45-degree field of view · 2352x1568px
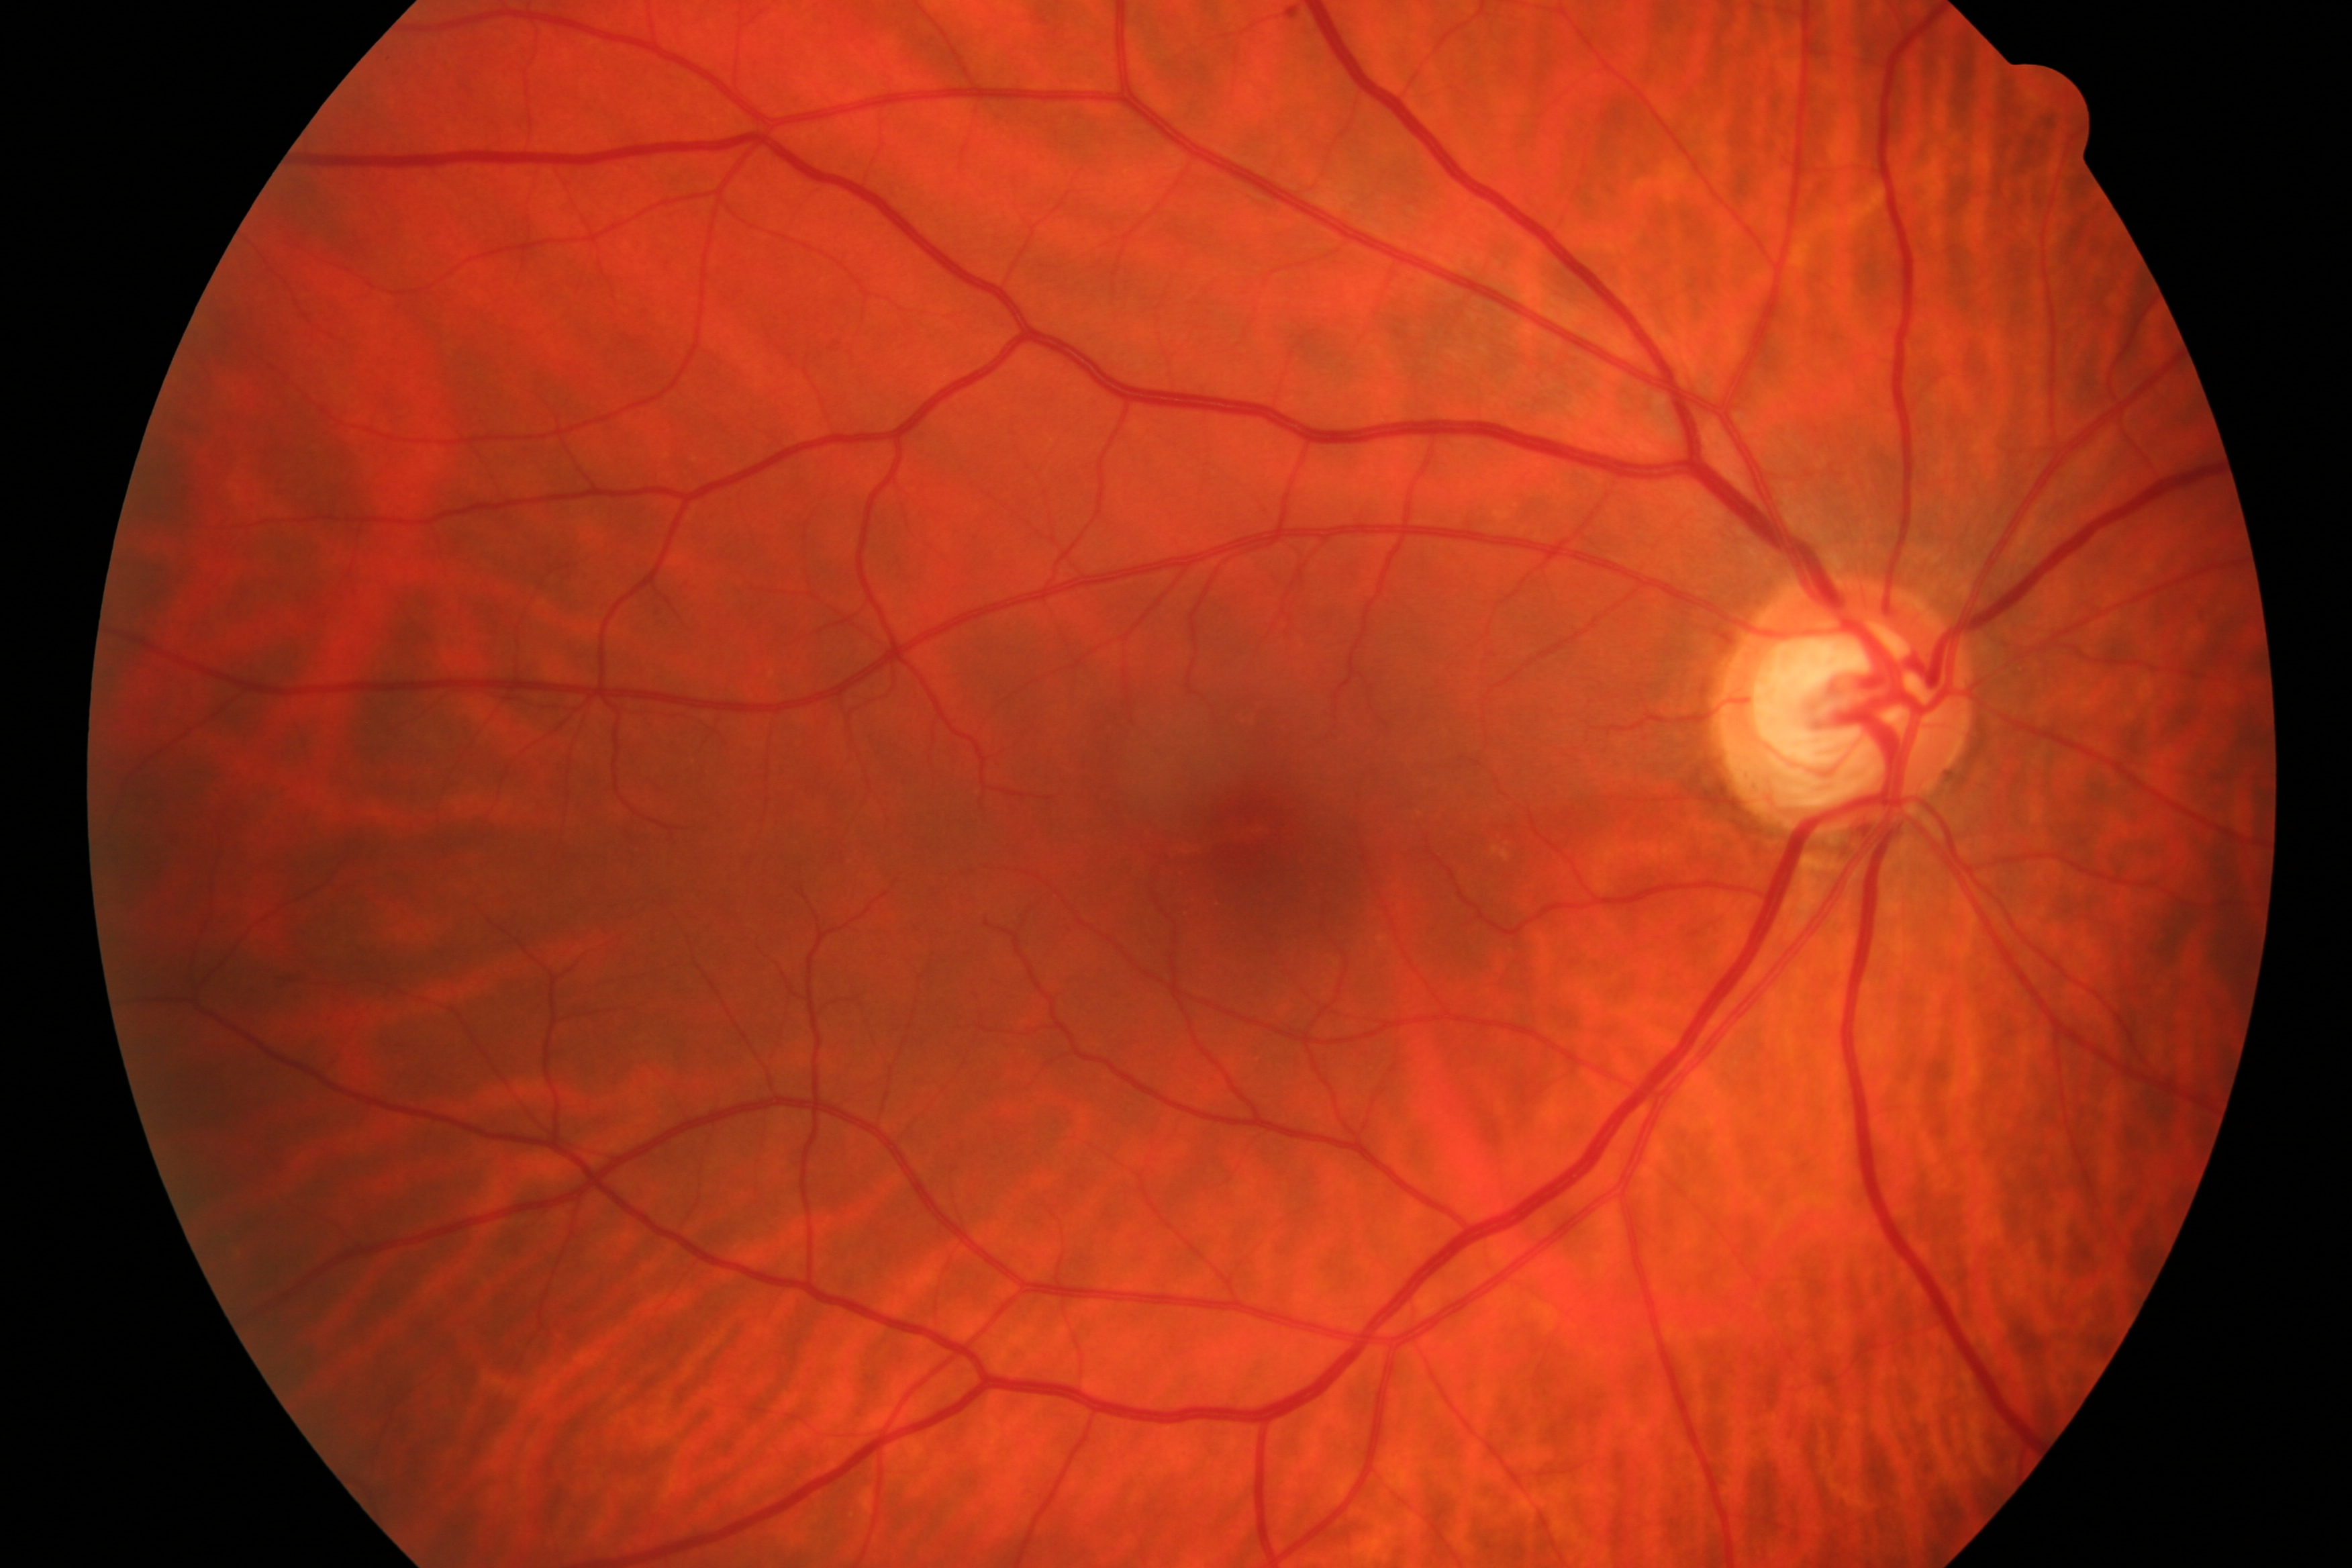

Showing glaucomatous optic neuropathy.